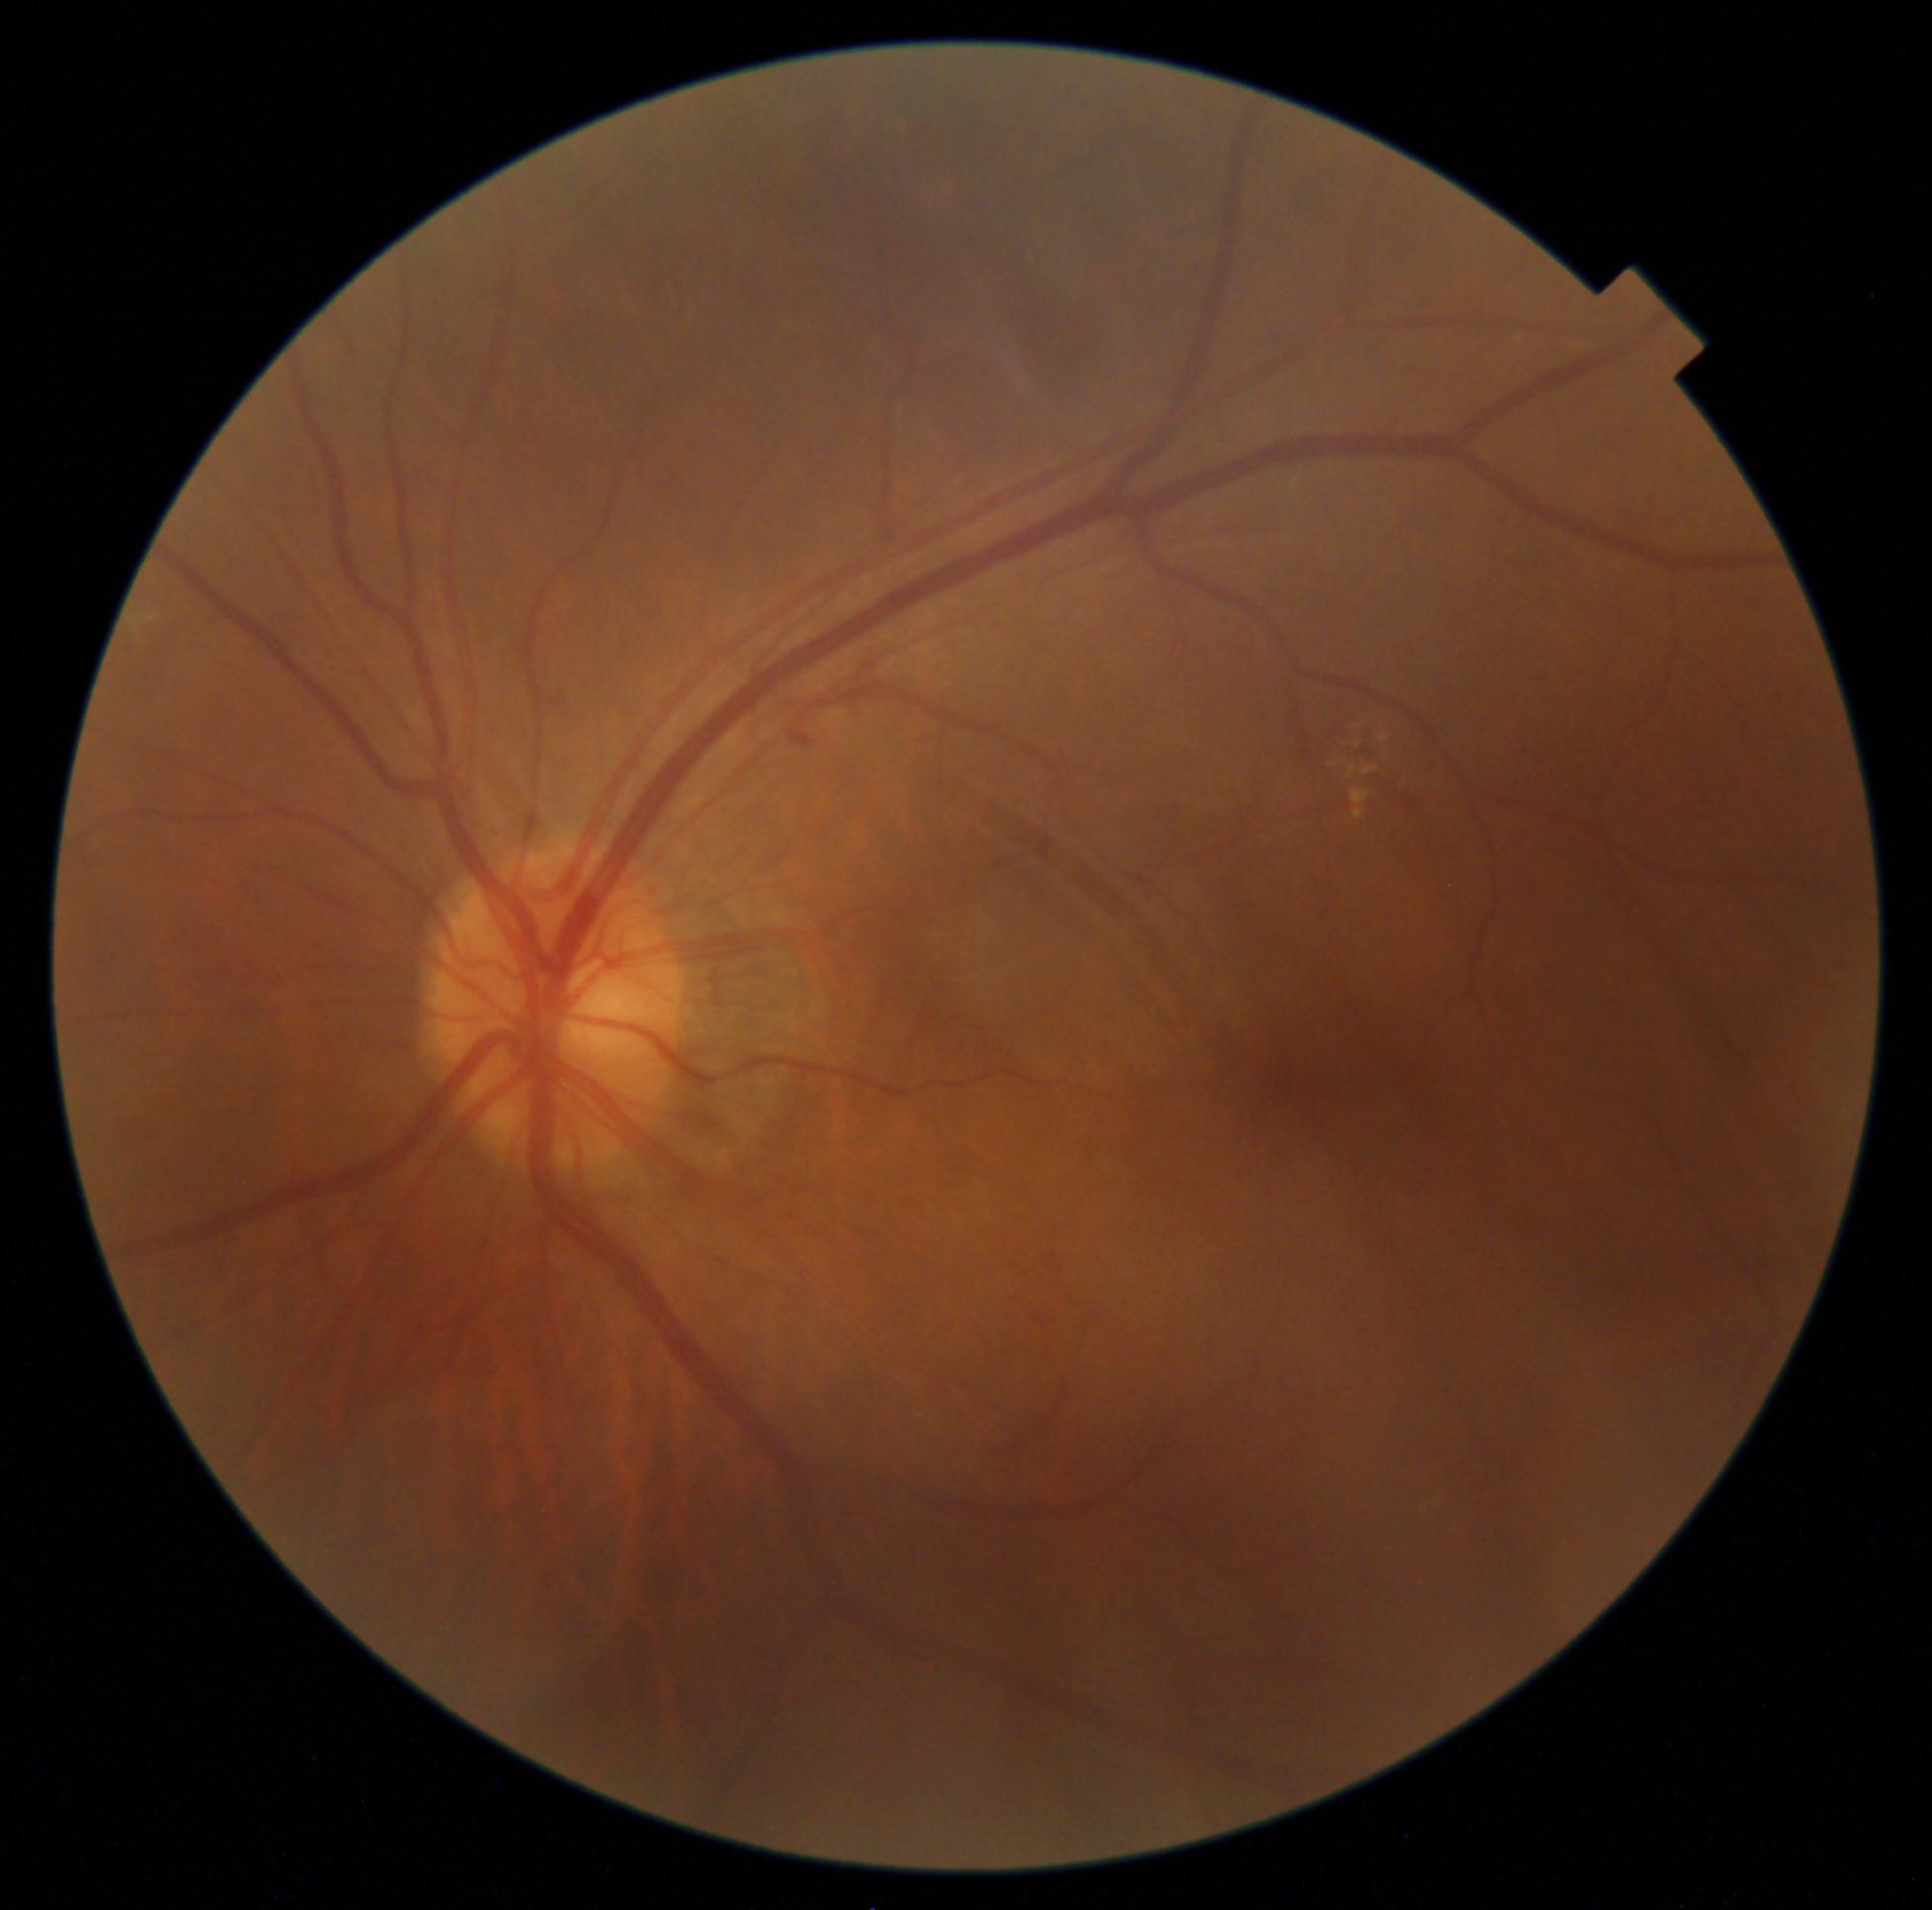

Annotations:
* DR grade — 2